FOV: 45 degrees, 2212x1659px, retinal fundus photograph — 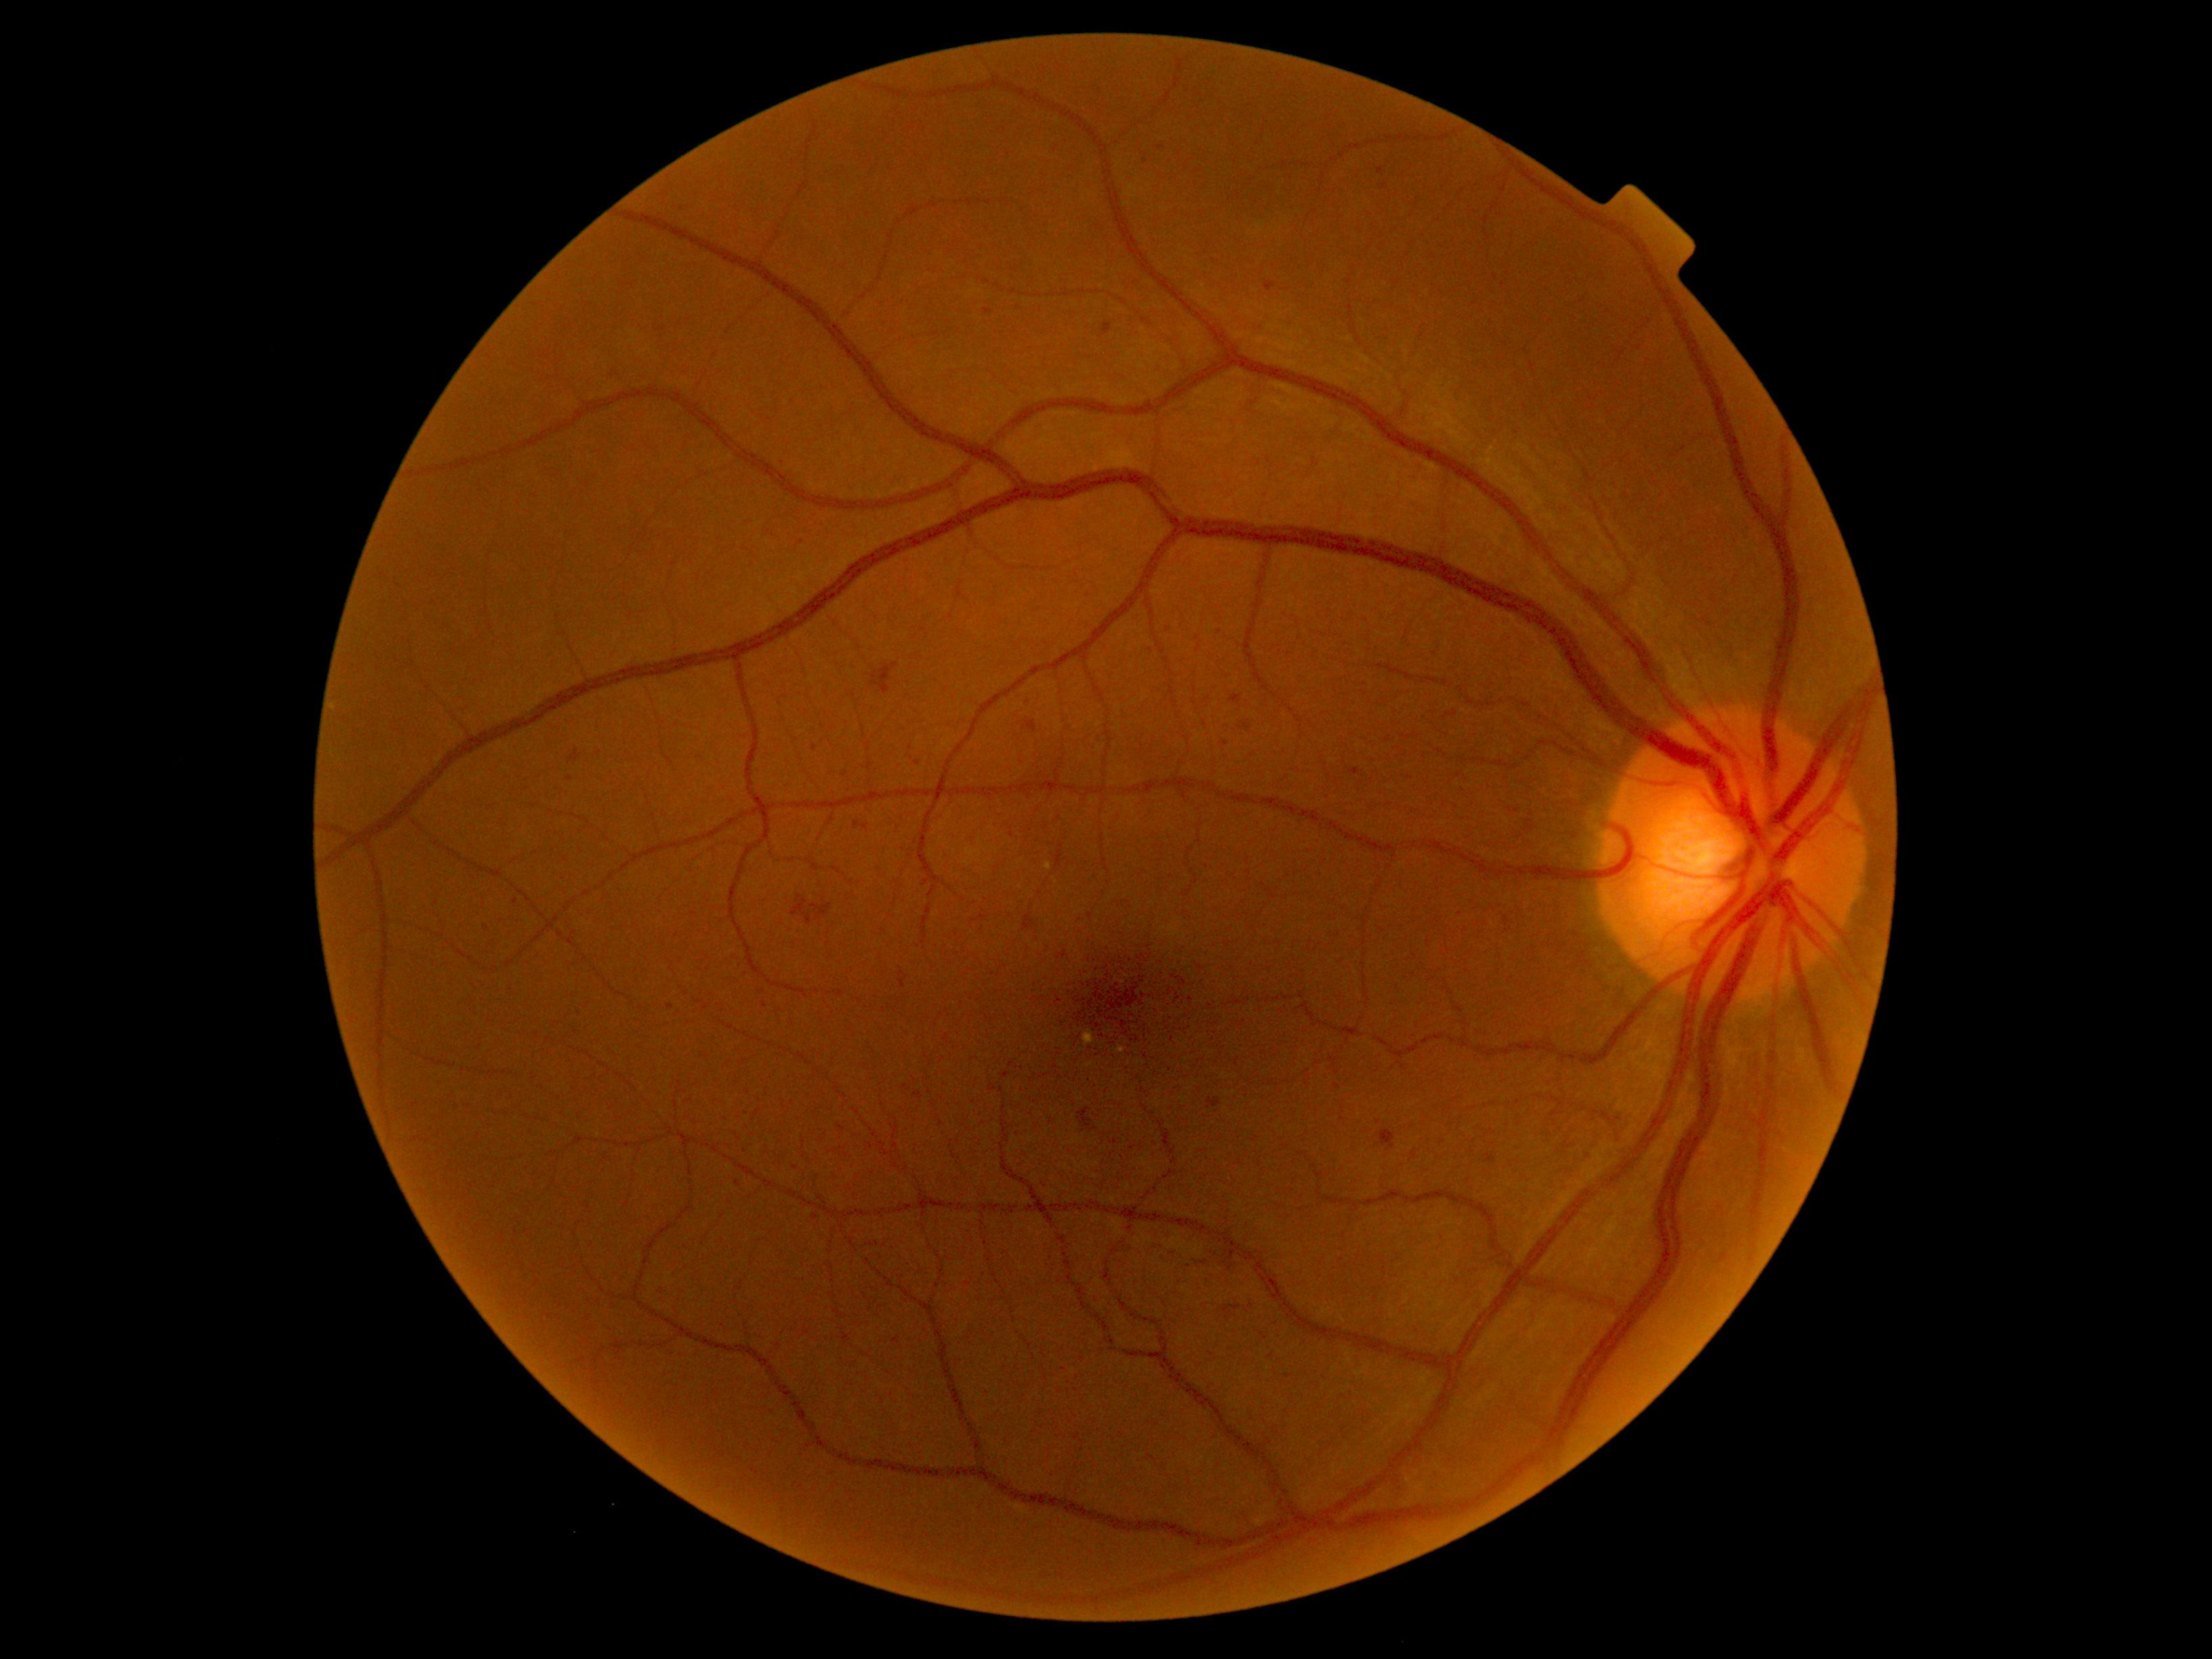

Diabetic retinopathy (DR): moderate NPDR (grade 2); non-proliferative diabetic retinopathy.
Hemorrhages (HEs) include those at Rect(567, 750, 581, 764), Rect(1184, 1256, 1200, 1272), Rect(1207, 1099, 1222, 1109), Rect(1120, 897, 1131, 907), Rect(893, 1337, 901, 1343), Rect(811, 903, 833, 921), Rect(1103, 325, 1111, 335), Rect(1283, 288, 1291, 292), Rect(1078, 918, 1088, 925), Rect(876, 302, 888, 310).
Small HEs approximately at (796,1167), (748,1091), (1146,163), (902,974), (570,779), (1270,1357), (815,748), (765,1005), (1381,170).